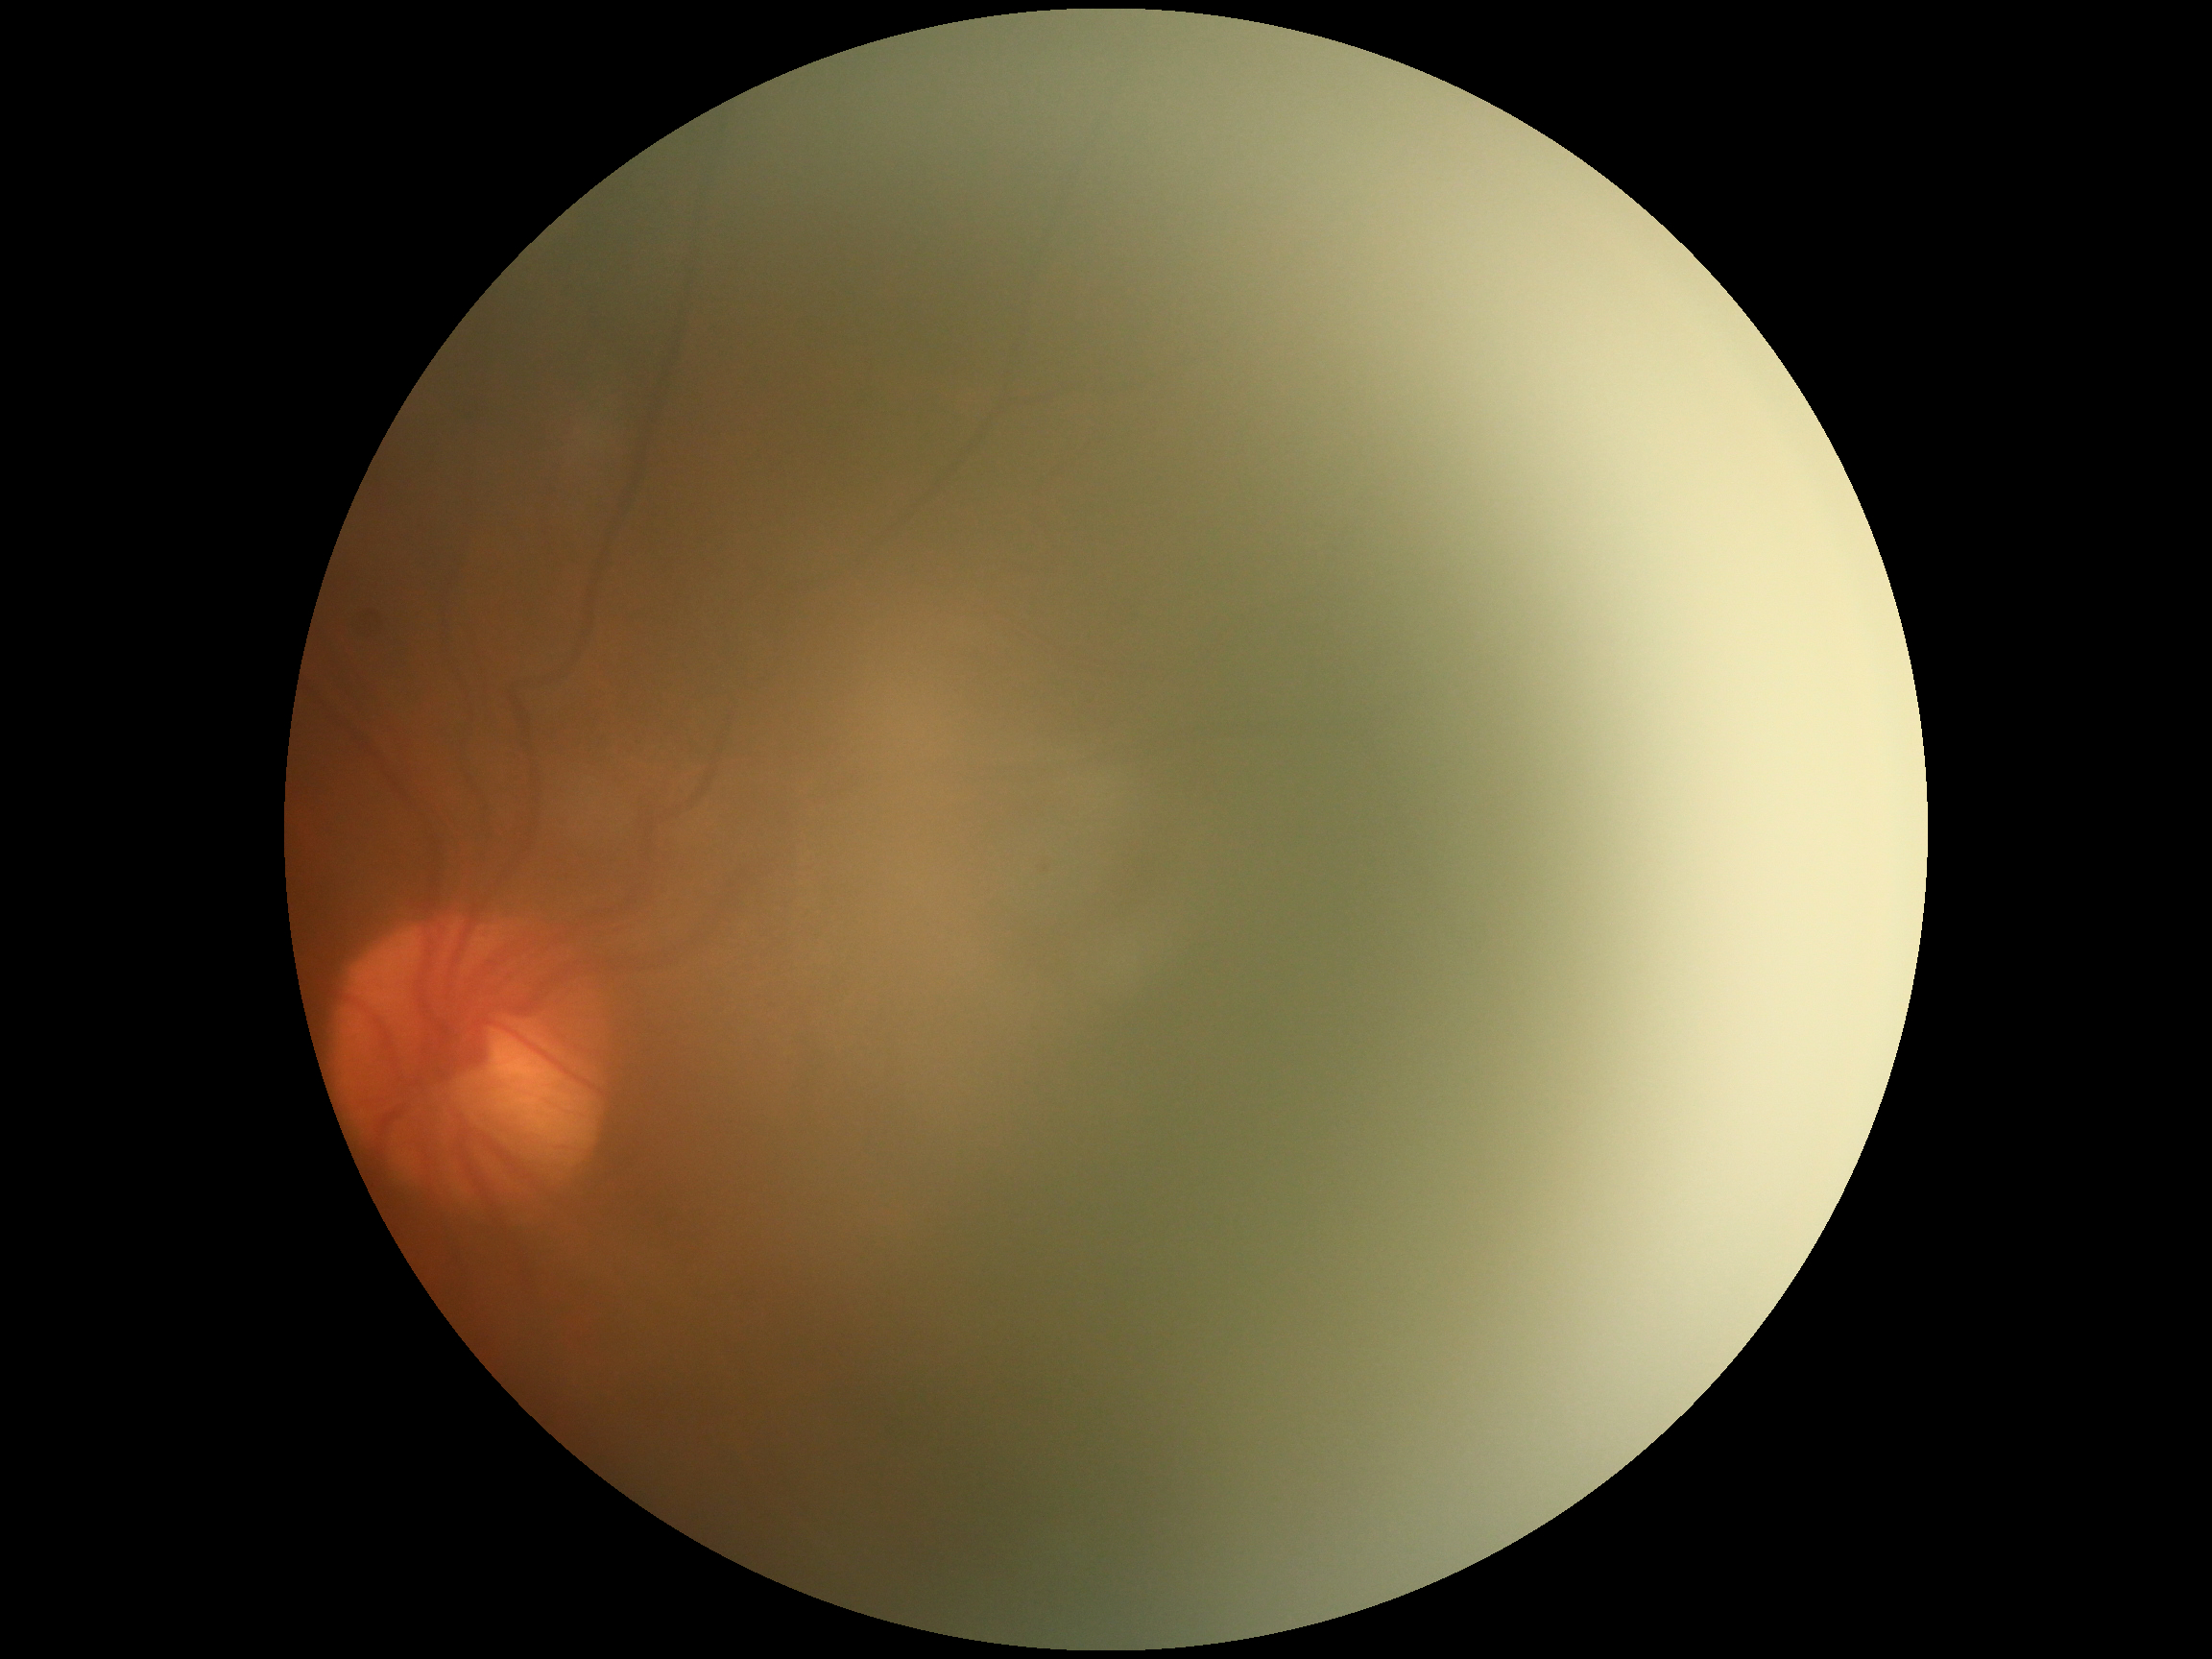 DR stage = ungradable due to poor image quality.